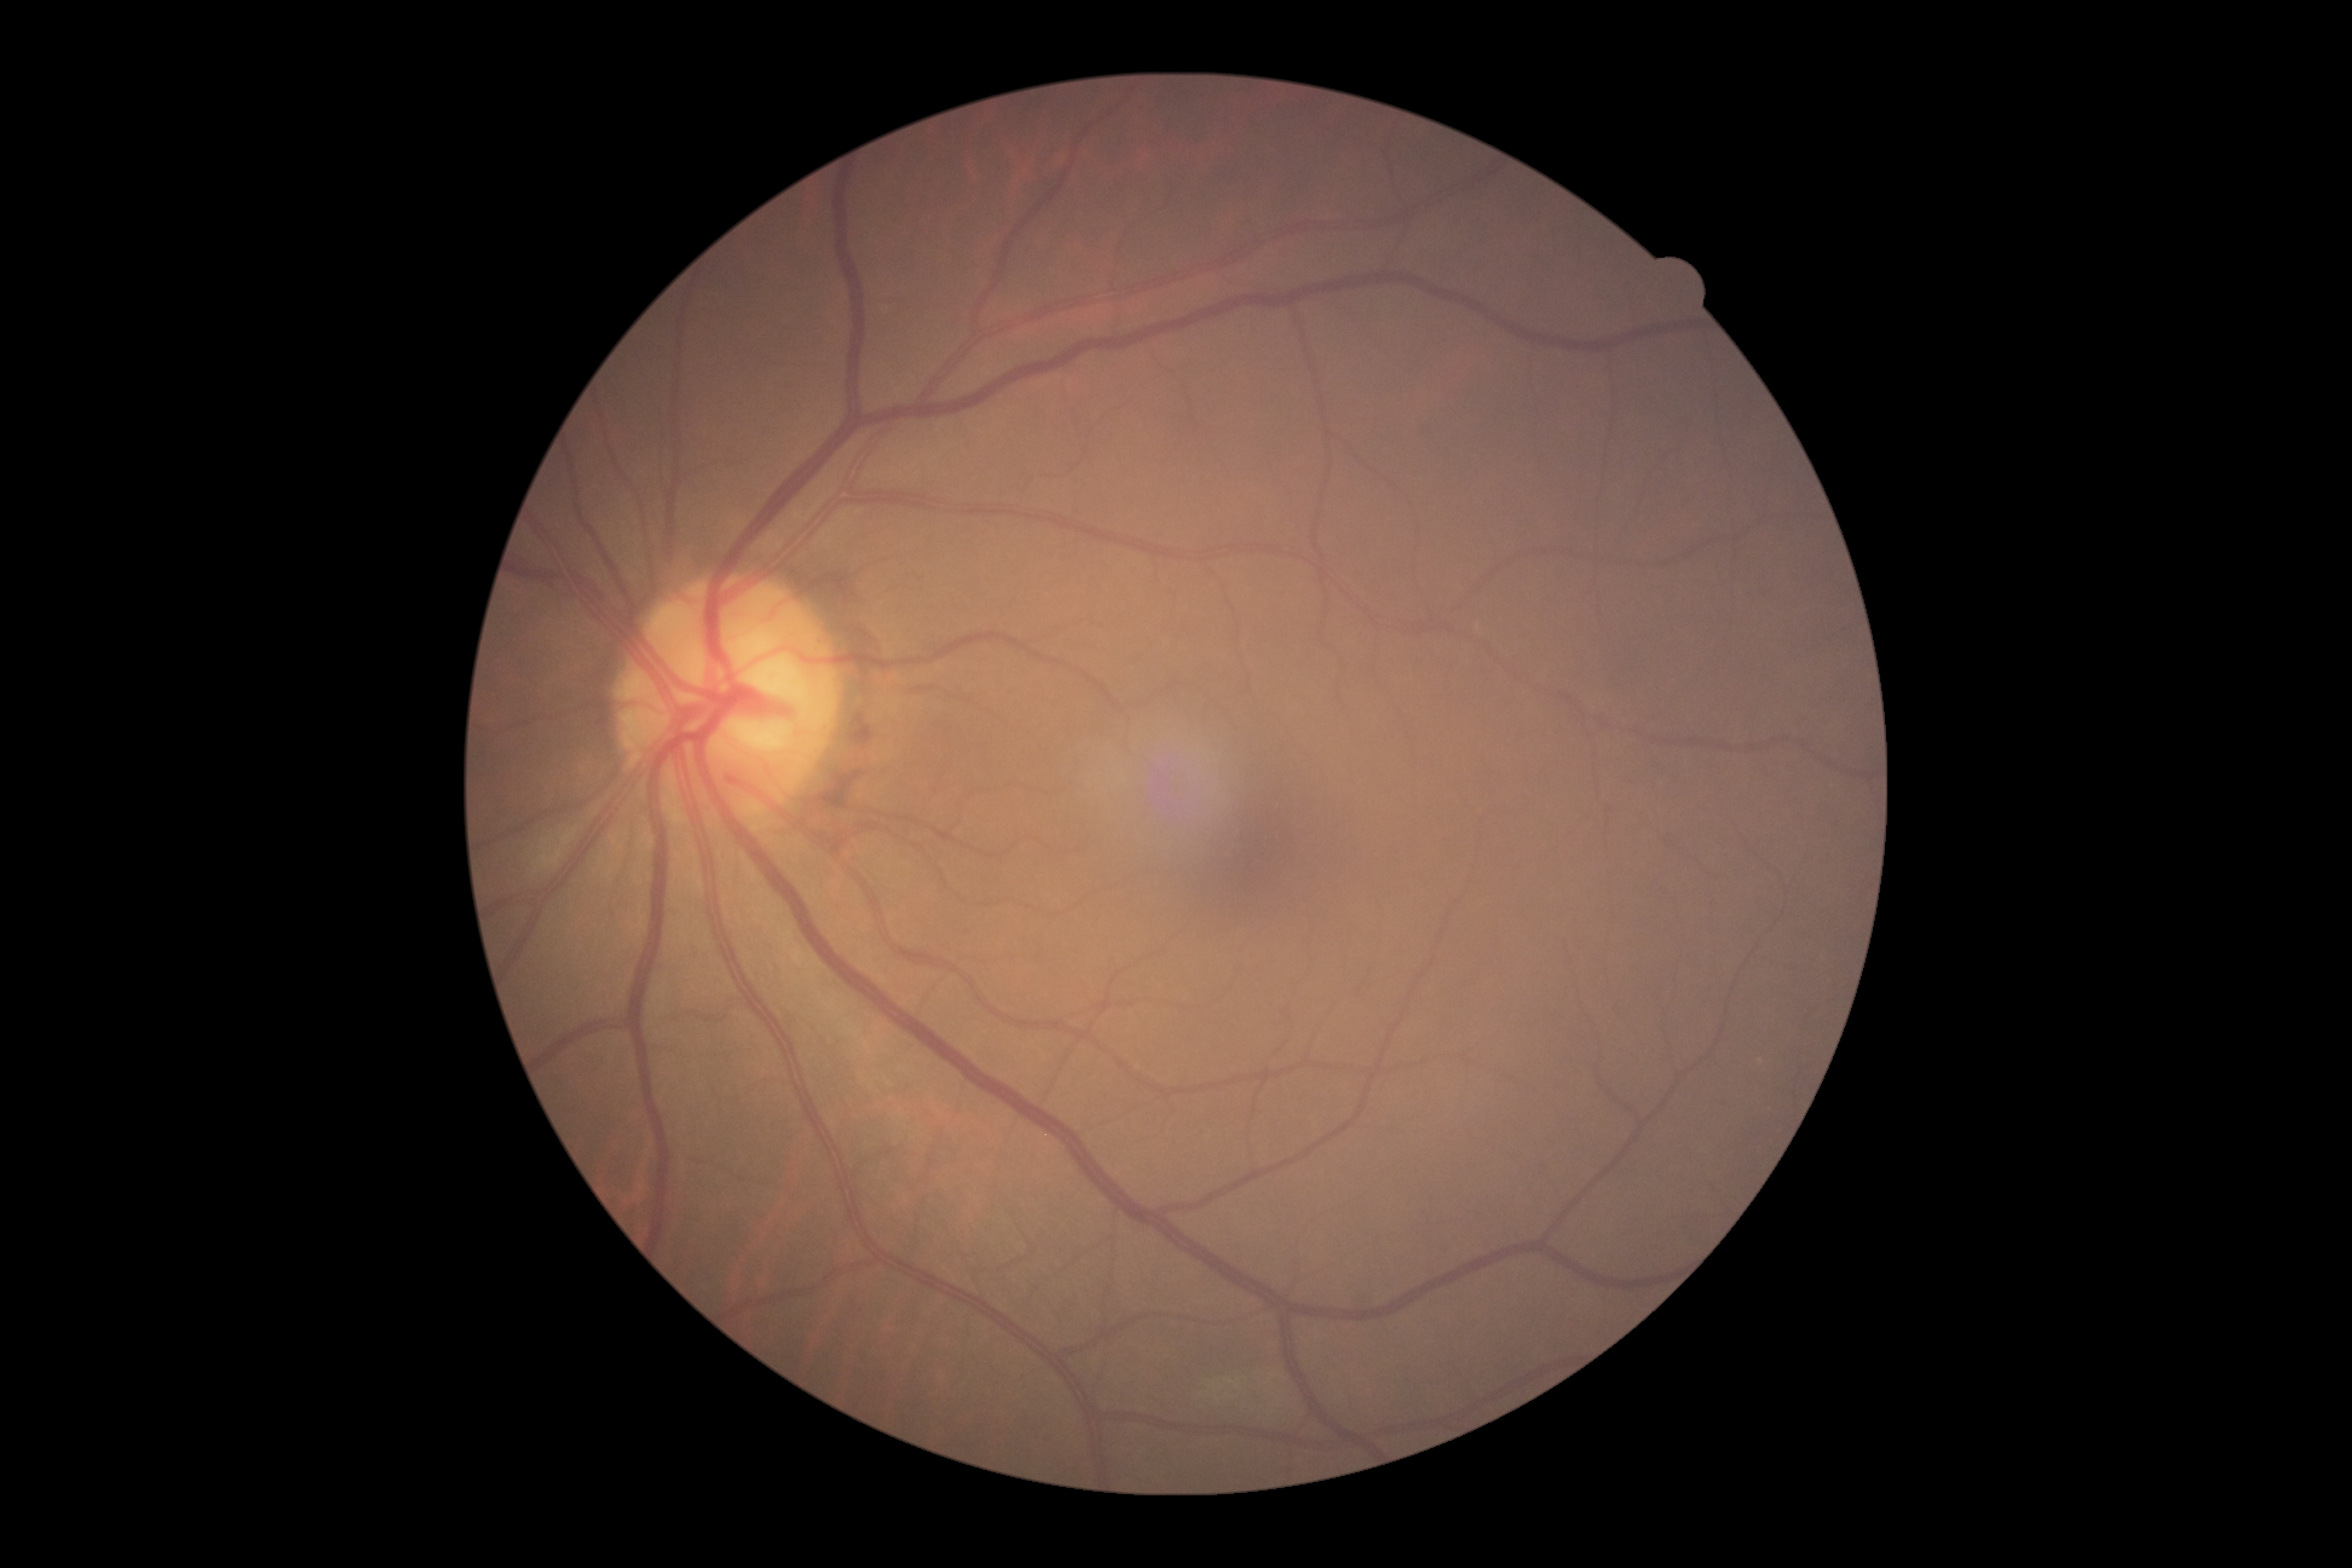
dr_grade: grade 0